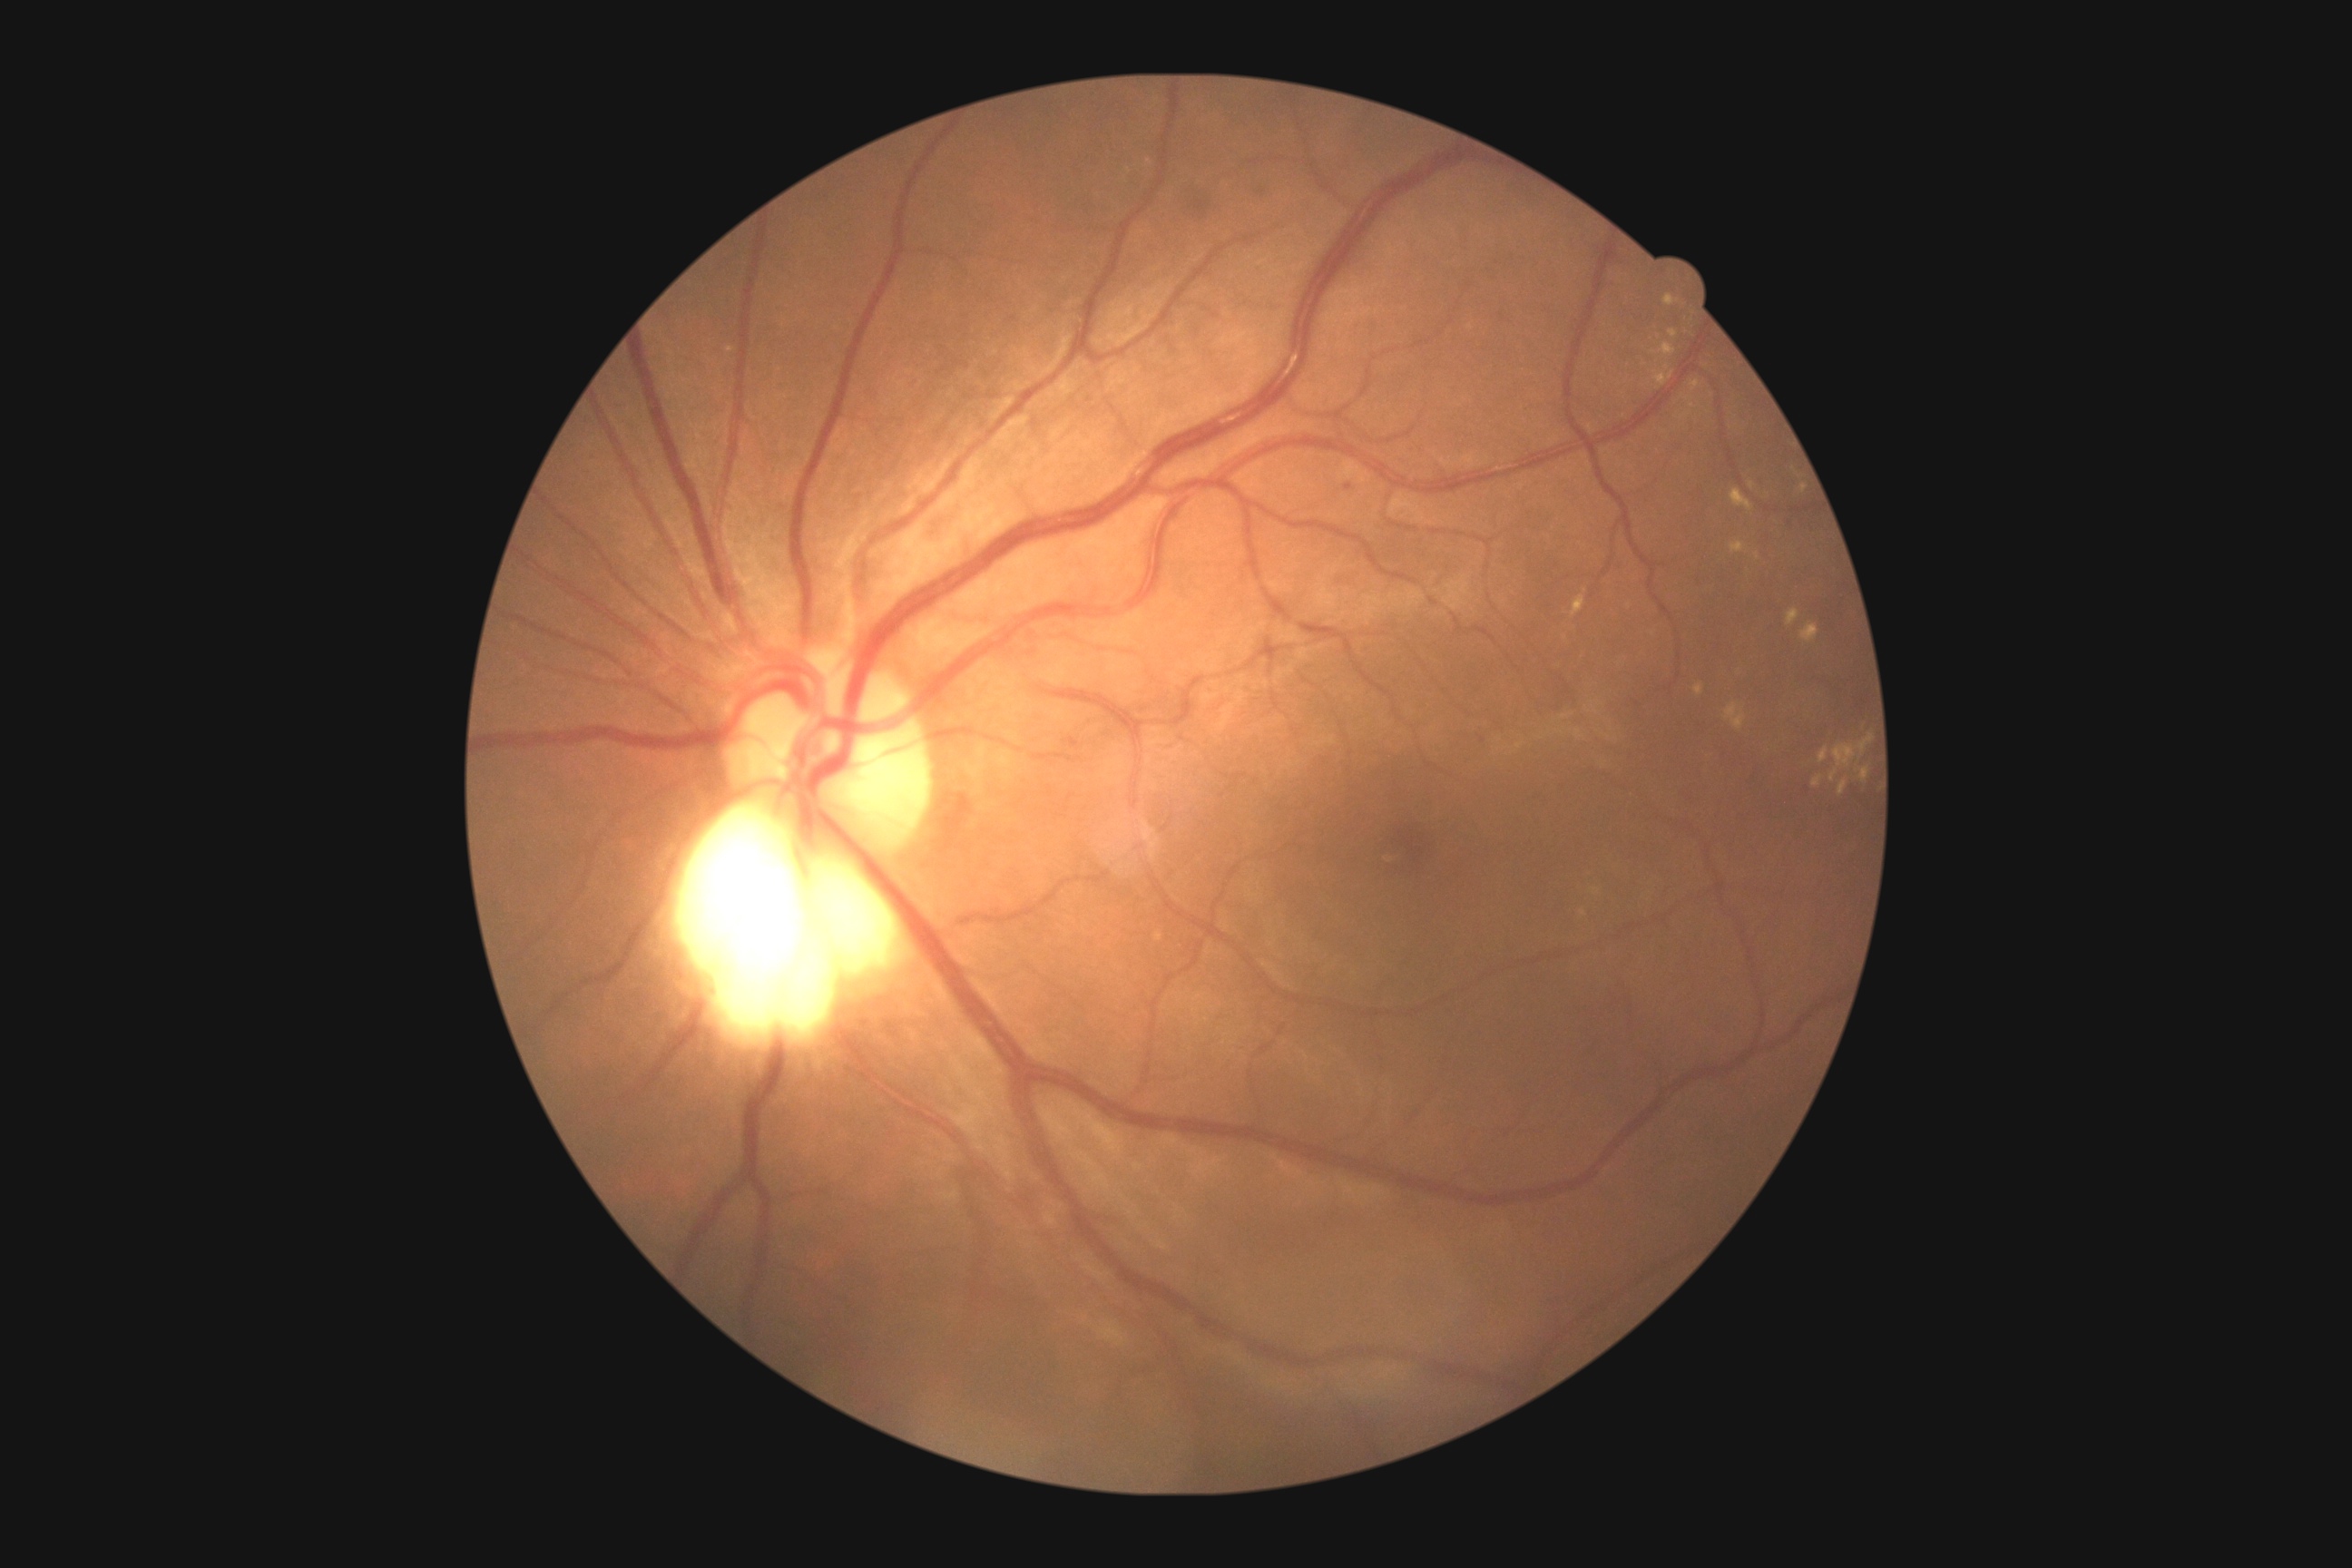
<lesions partial="true">
  <dr_grade>2</dr_grade>
  <se />
  <ex partial="true">(x1=1830, y1=734, x2=1874, y2=783) | (x1=1730, y1=489, x2=1754, y2=513) | (x1=1787, y1=609, x2=1799, y2=627) | (x1=1694, y1=685, x2=1703, y2=696) | (x1=1669, y1=329, x2=1680, y2=338) | (x1=1799, y1=484, x2=1807, y2=495) | (x1=1663, y1=295, x2=1680, y2=308) | (x1=1801, y1=622, x2=1819, y2=643) | (x1=1819, y1=747, x2=1828, y2=763) | (x1=1812, y1=776, x2=1823, y2=789)</ex>
  <ex_small>{"x": 1584, "y": 913} | {"x": 1693, "y": 406} | {"x": 1585, "y": 591}</ex_small>
  <ma />
  <he>(x1=1064, y1=738, x2=1079, y2=750) | (x1=1344, y1=484, x2=1353, y2=491) | (x1=1193, y1=201, x2=1210, y2=219)</he>
  <he_small>{"x": 1263, "y": 193}</he_small>
</lesions>